45° field of view · modified Davis classification.
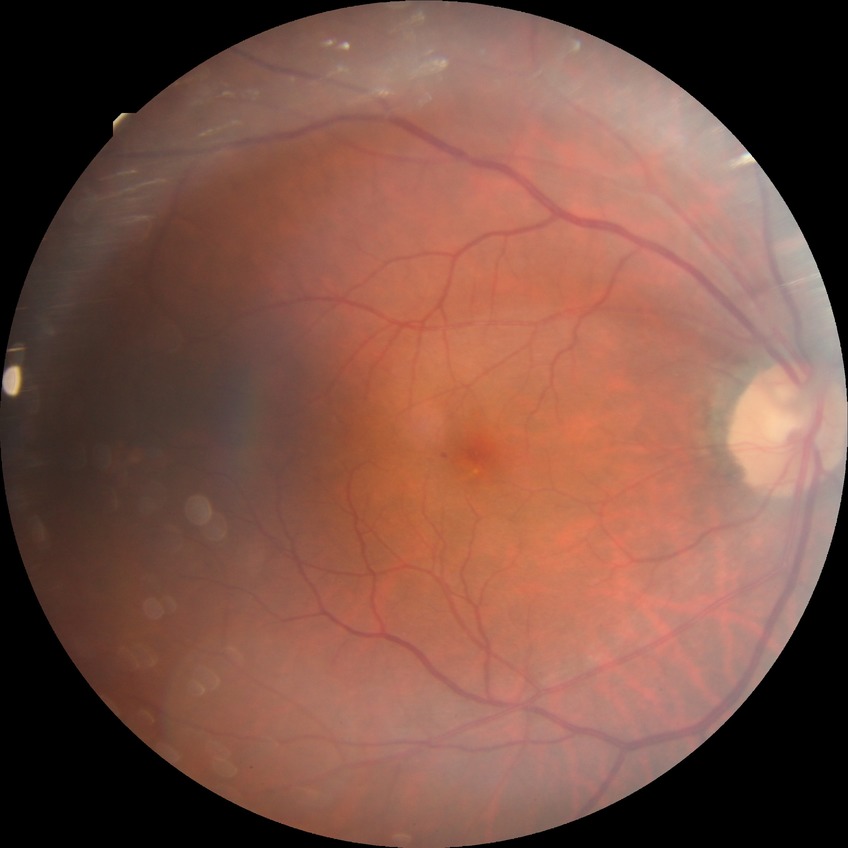
  davis_grade: SDR